Acquired with a NIDEK AFC-230 — 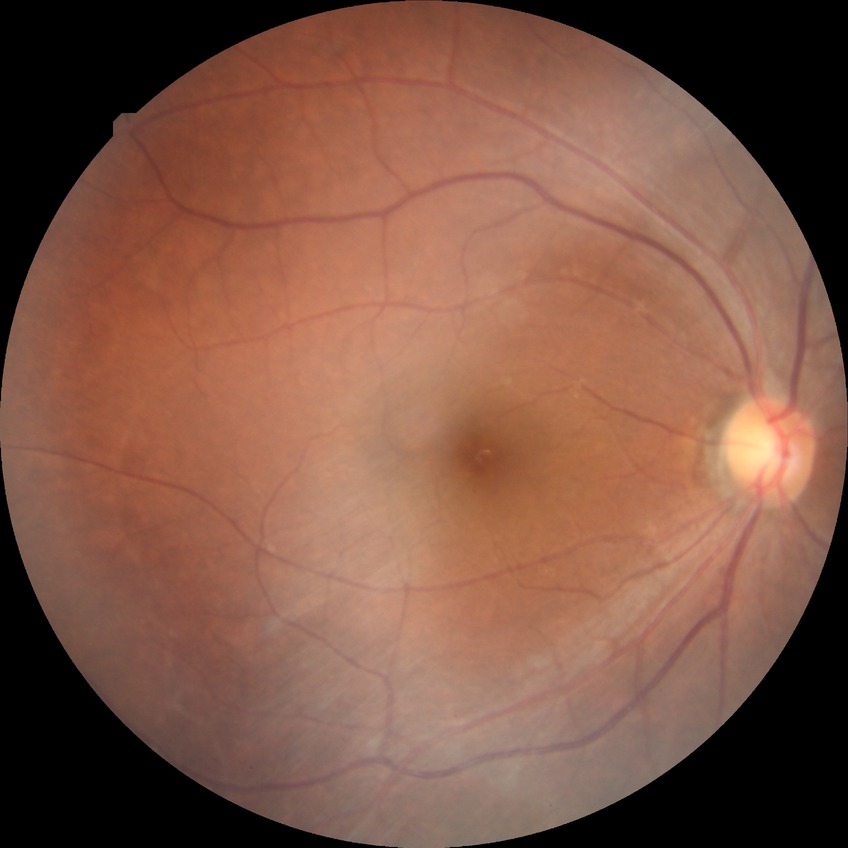 Diabetic retinopathy (DR) is NDR (no diabetic retinopathy).